Optic disc-centered crop, 240 x 240 pixels: 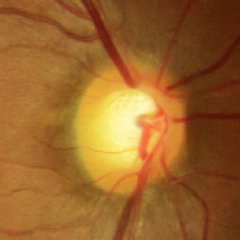

Fundus image with findings of no glaucomatous changes.